DR severity per modified Davis staging — 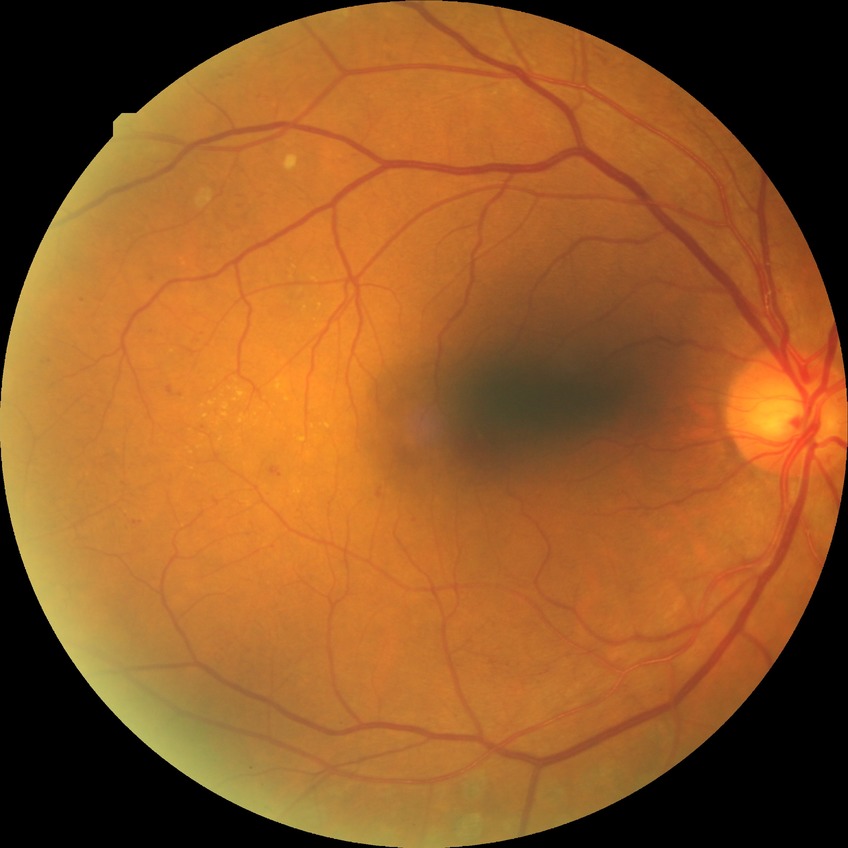

Davis stage is PPDR.